CFP · 2212 by 1659 pixels · 45-degree field of view.
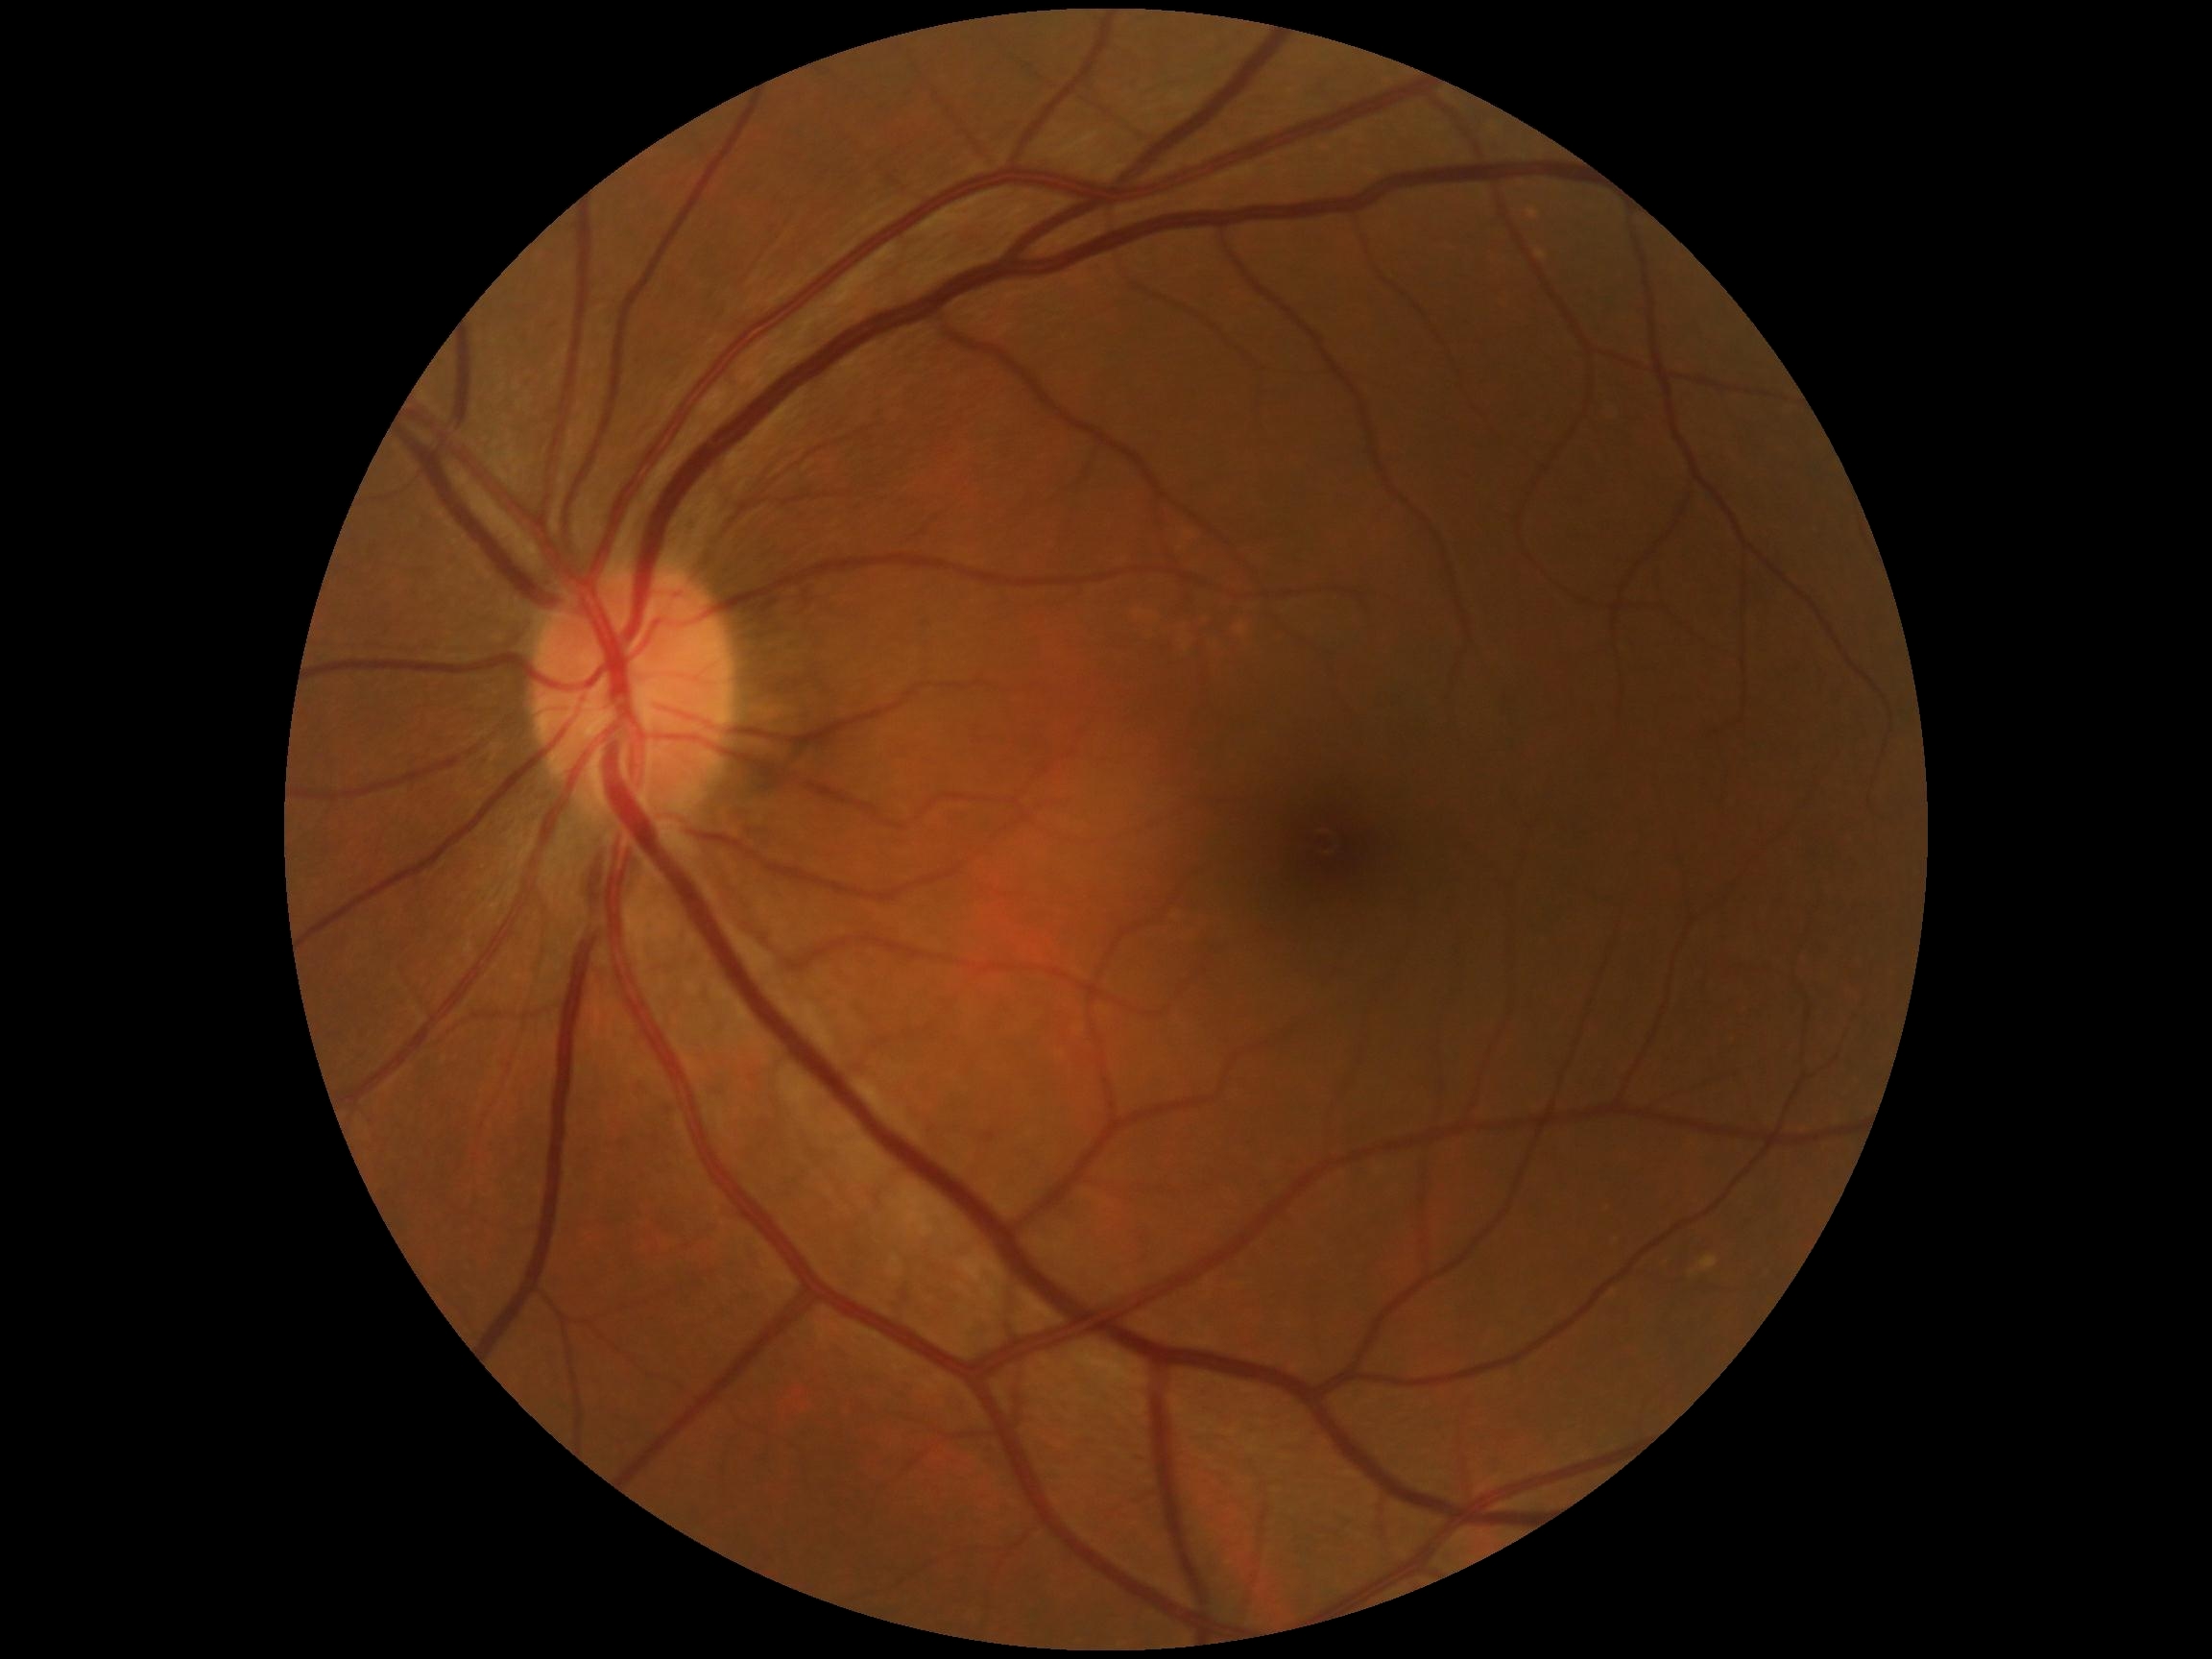 No diabetic retinal disease findings.
Diabetic retinopathy (DR) is 0/4.